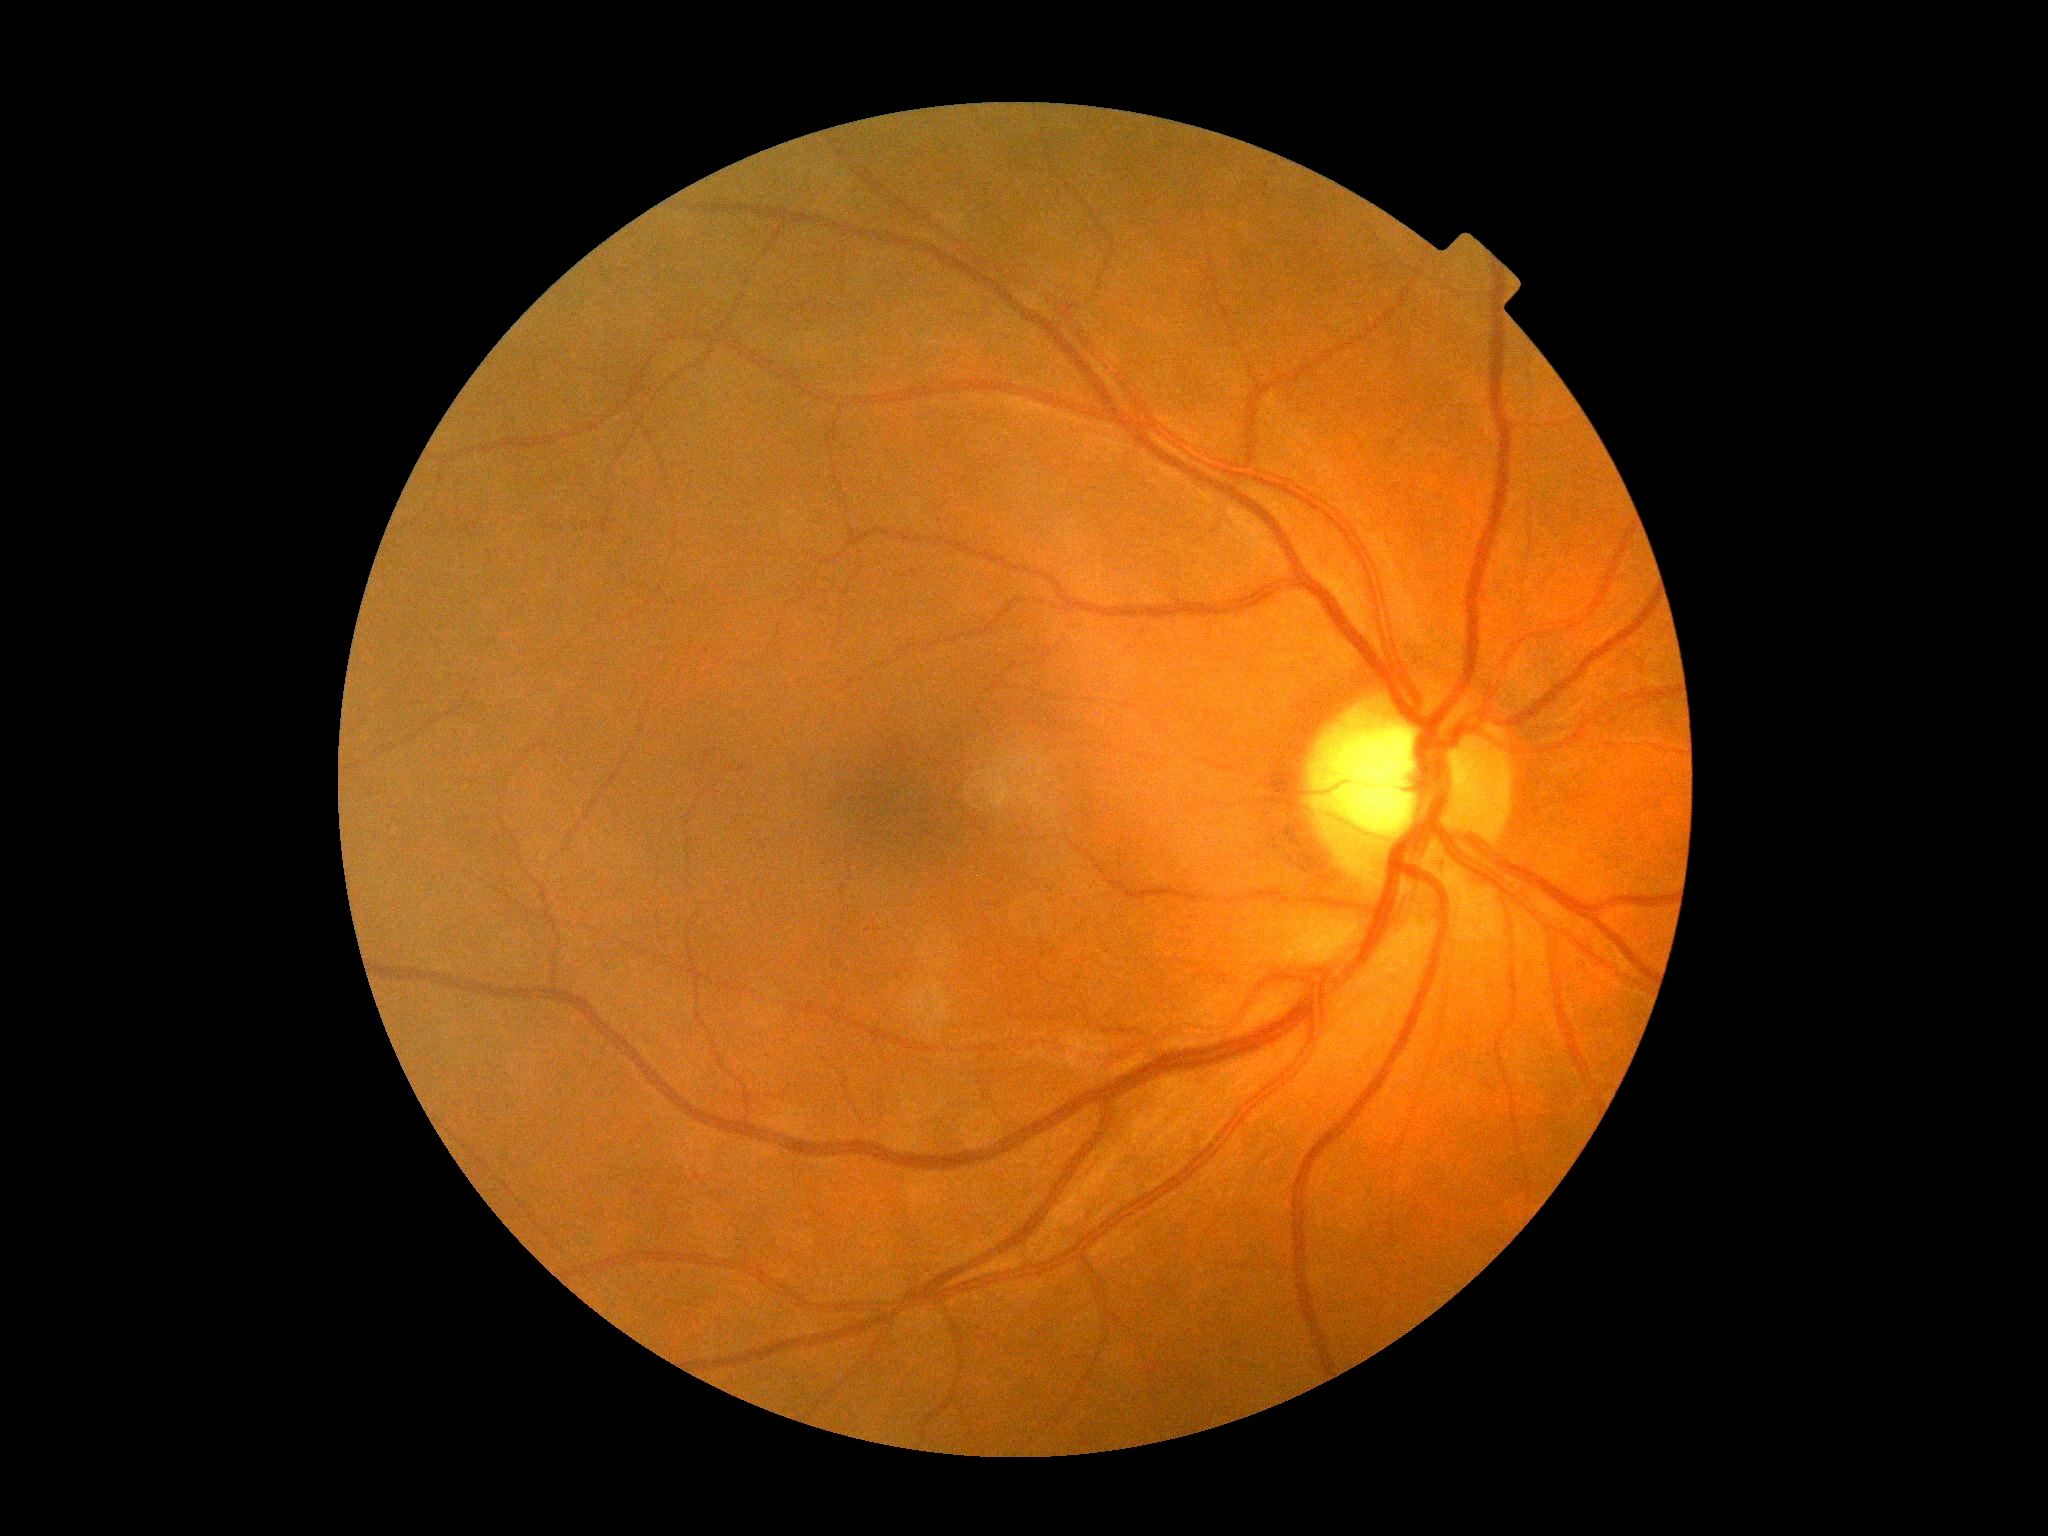

{
  "dr_impression": "no apparent DR",
  "dr_grade": "grade 0 (no apparent retinopathy) — no visible signs of diabetic retinopathy"
}